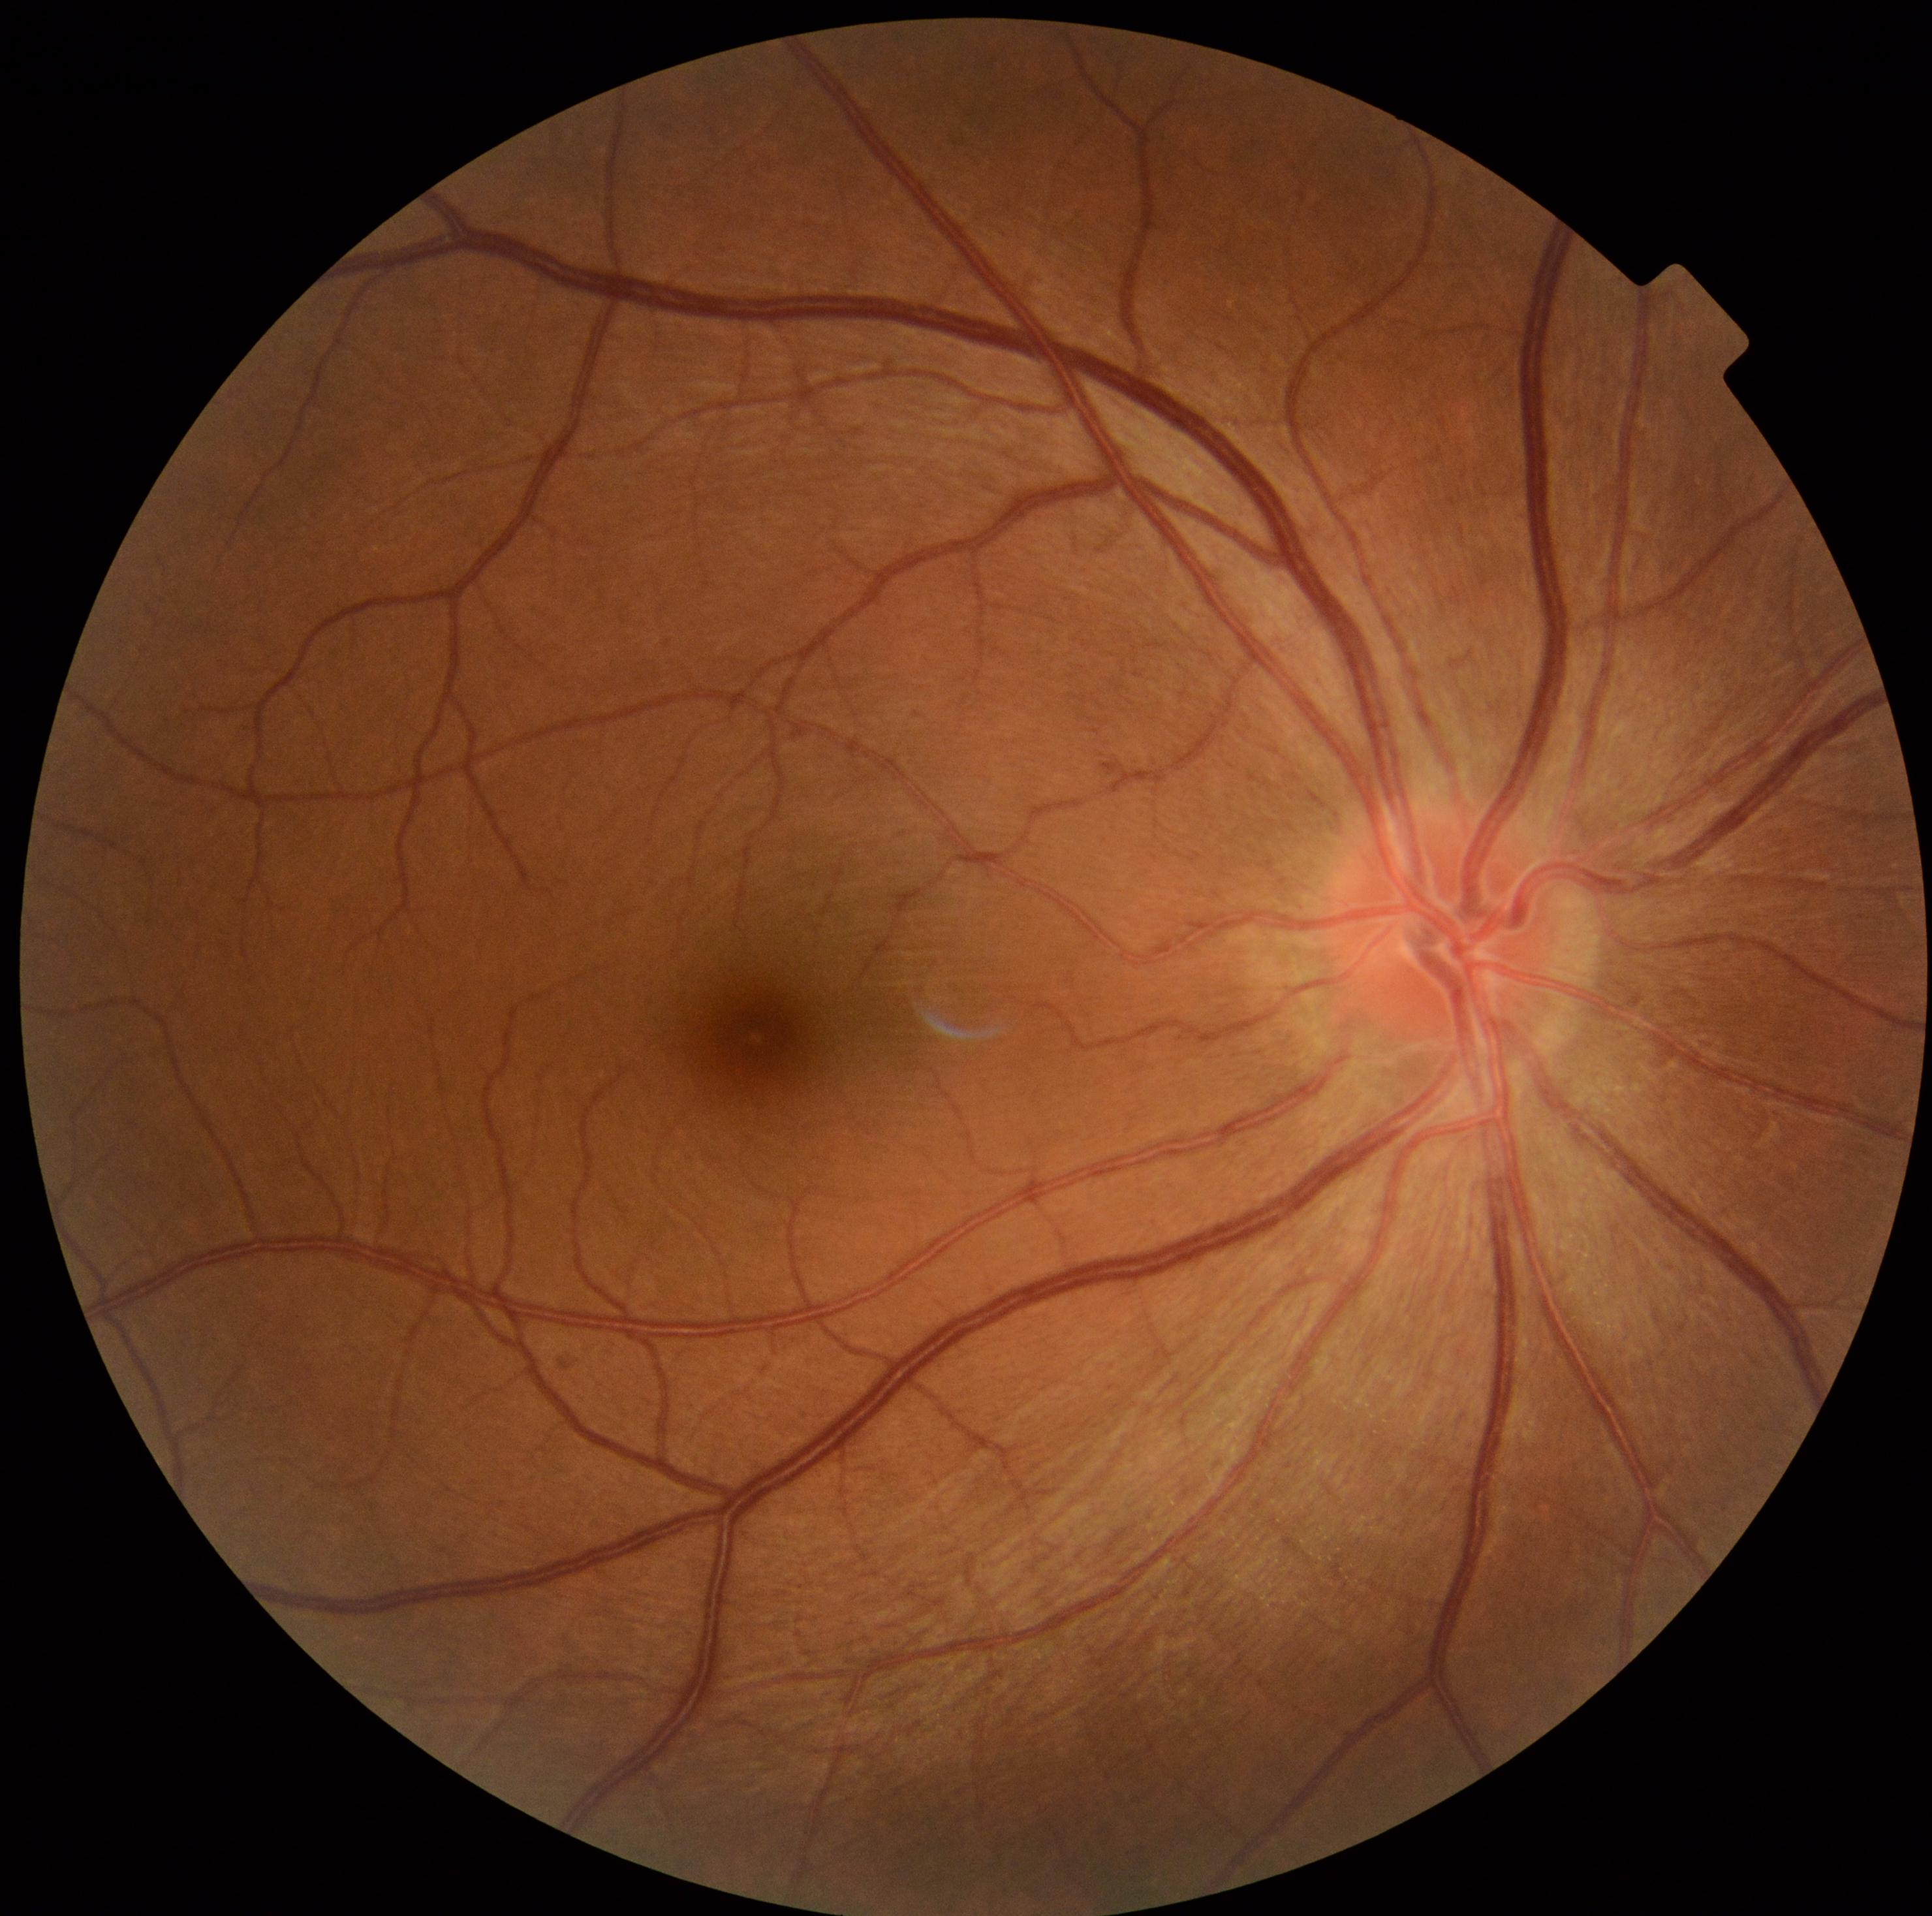

Retinopathy: grade 0.